Modified Davis grading, color fundus image, camera: NIDEK AFC-230:
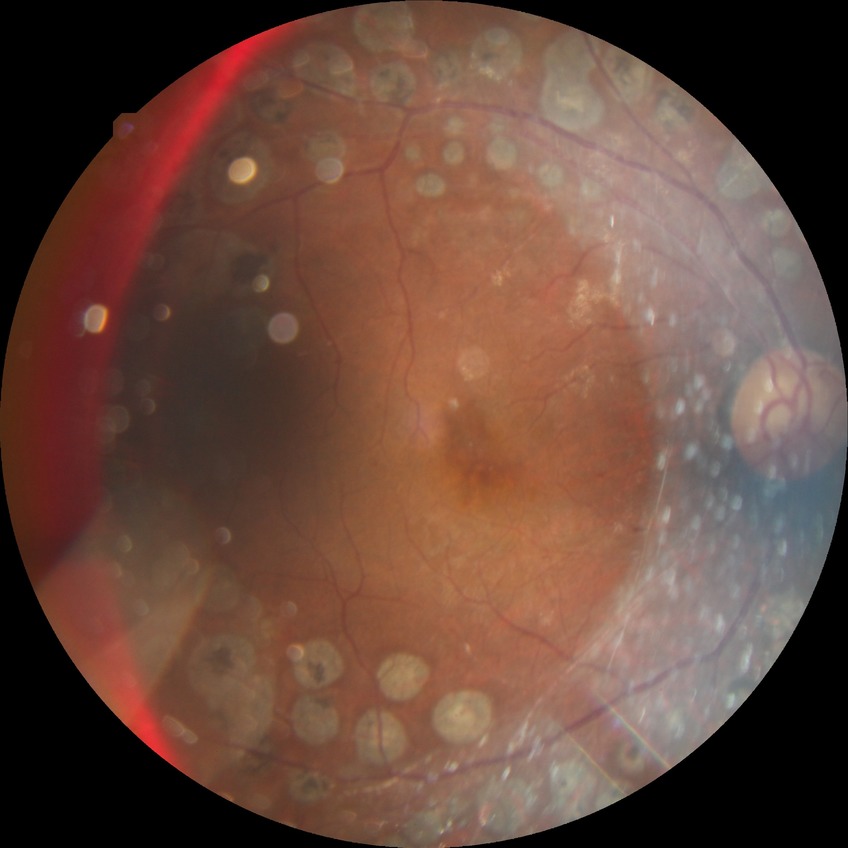

Diabetic retinopathy (DR): proliferative diabetic retinopathy (PDR).